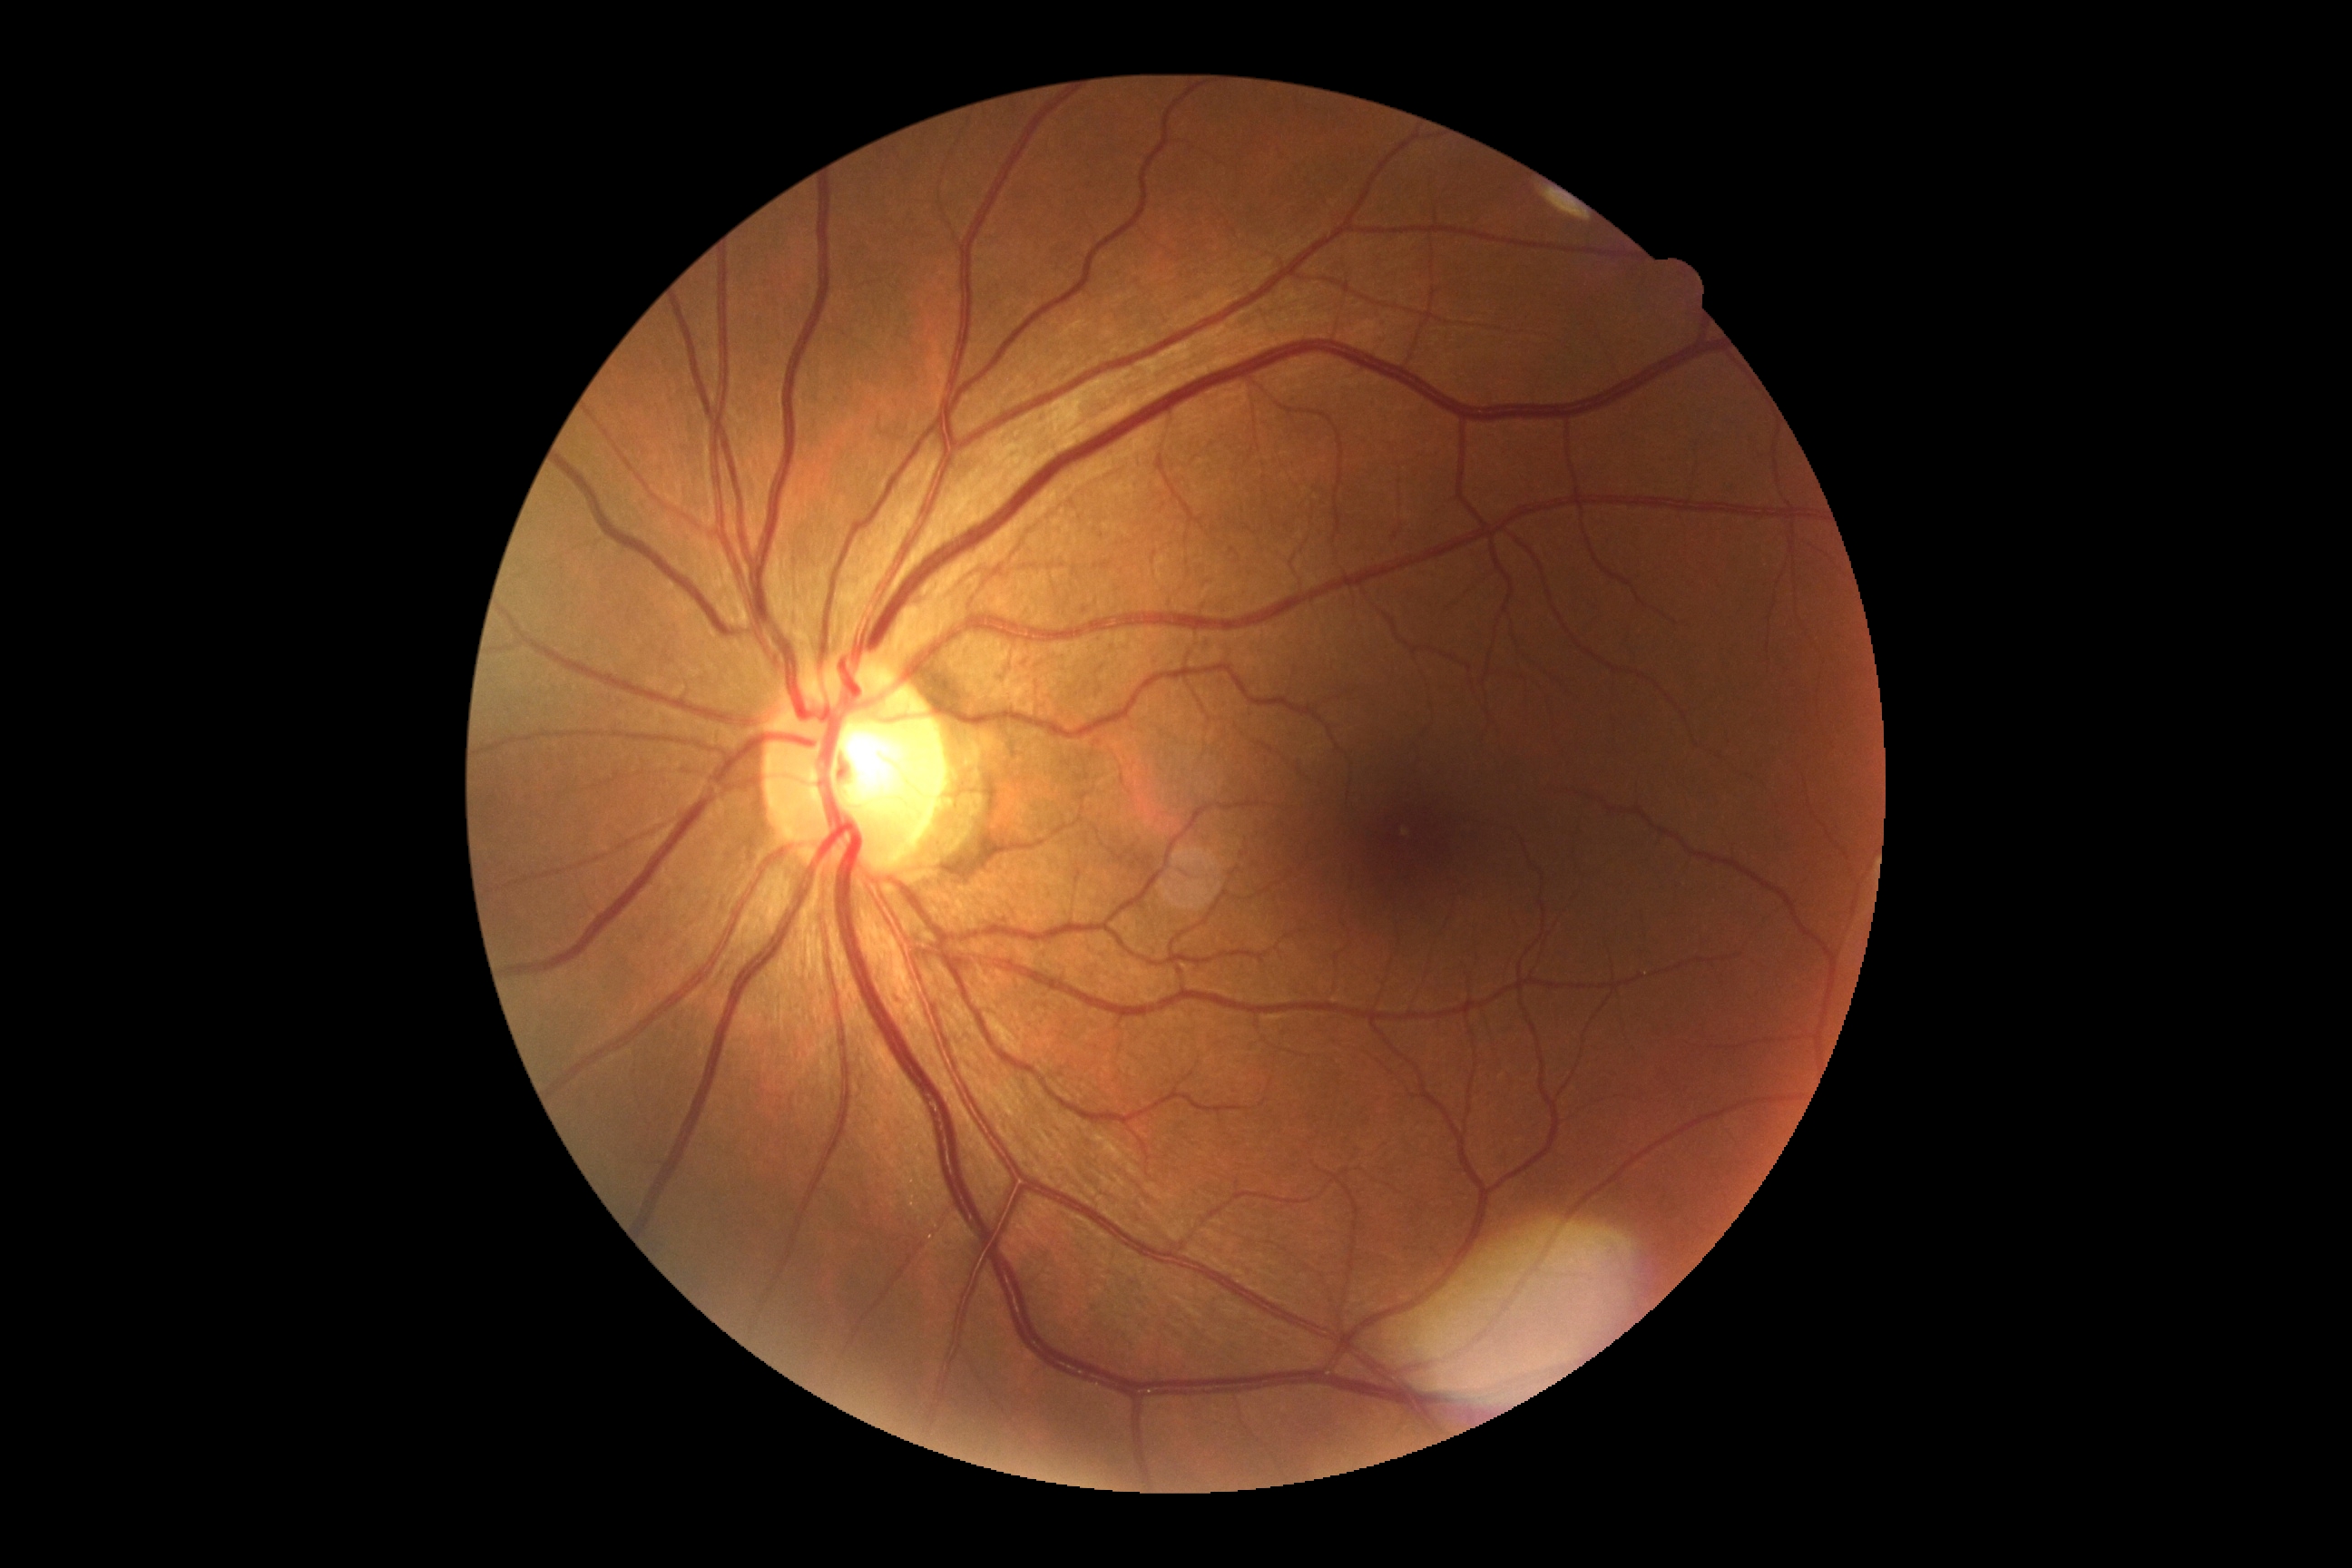 DR: 0/4.